CFP — 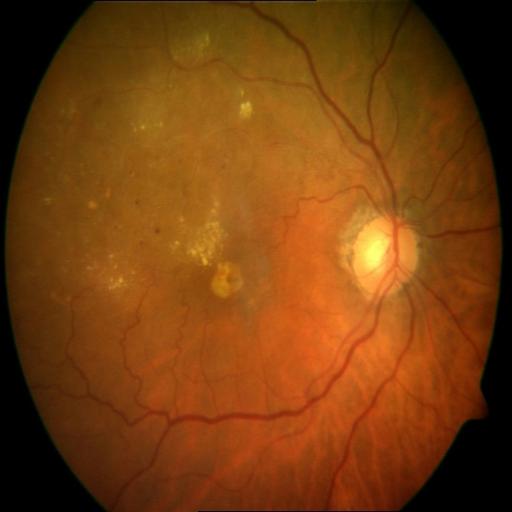
Findings: chorioretinitis.